Retinal fundus photograph · 45-degree field of view — 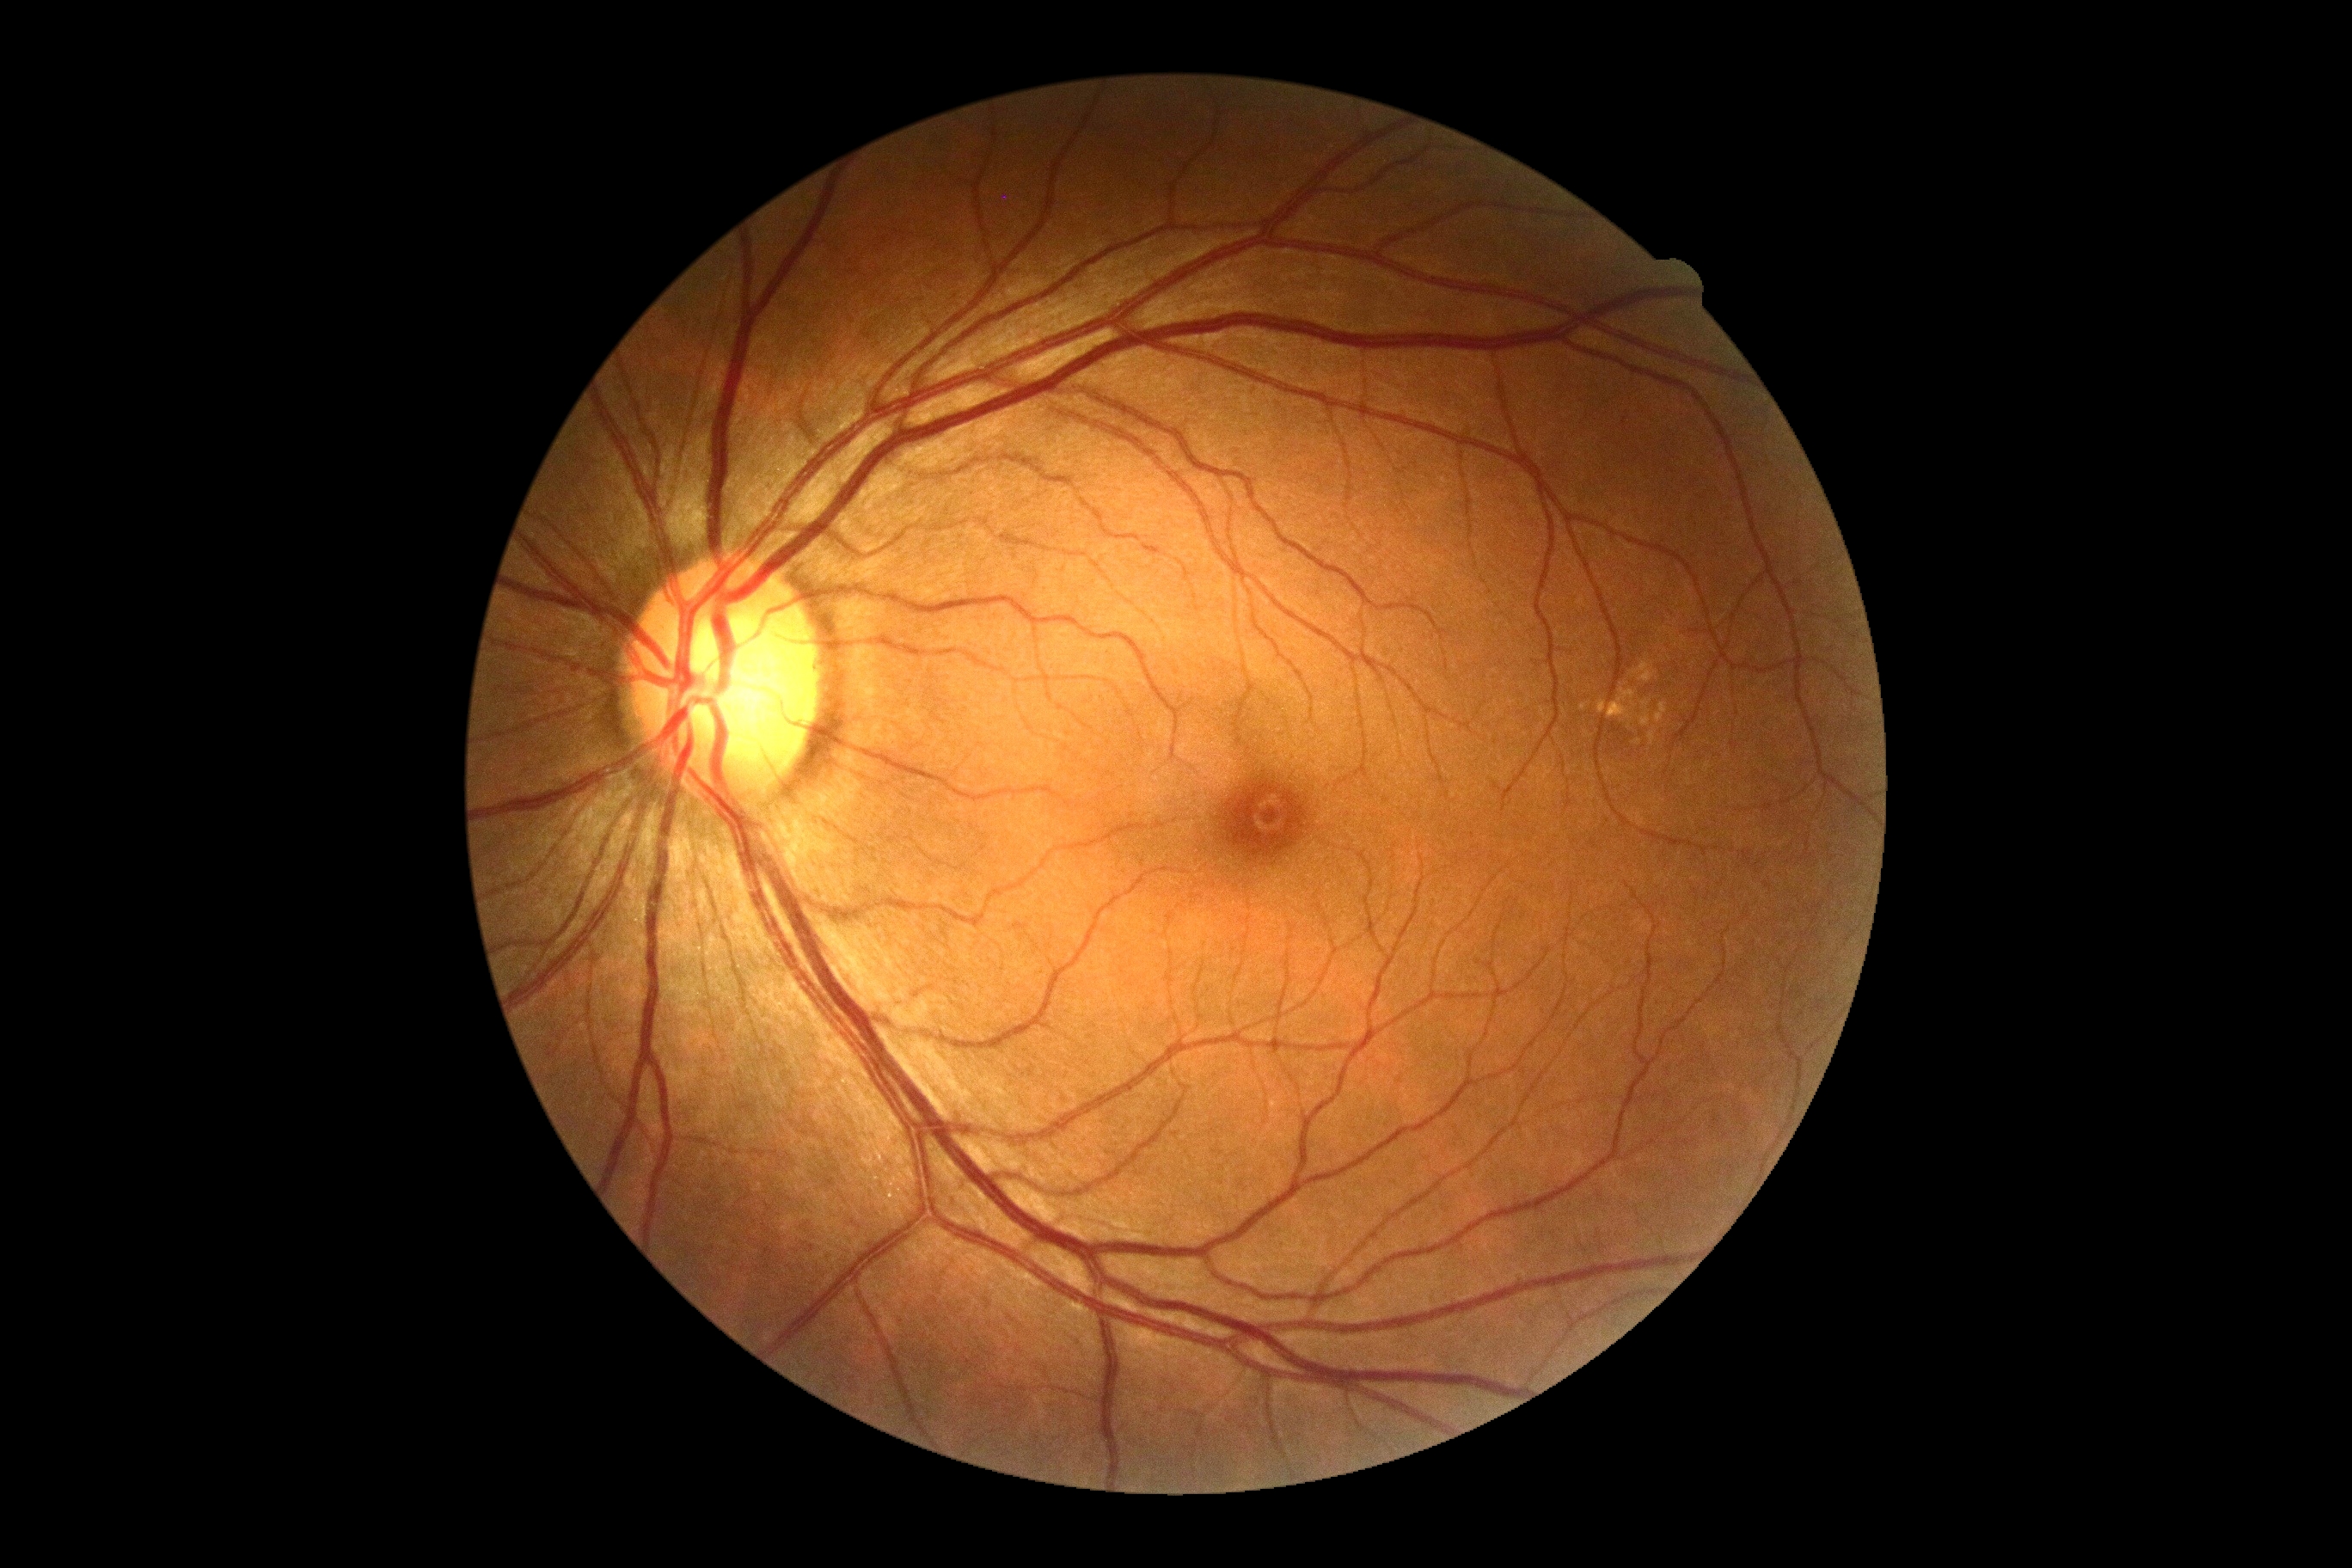 DR impression = no apparent DR | DR = no apparent diabetic retinopathy (grade 0) — no visible signs of diabetic retinopathy.